Acquired on the Phoenix ICON · pediatric retinal photograph (wide-field)
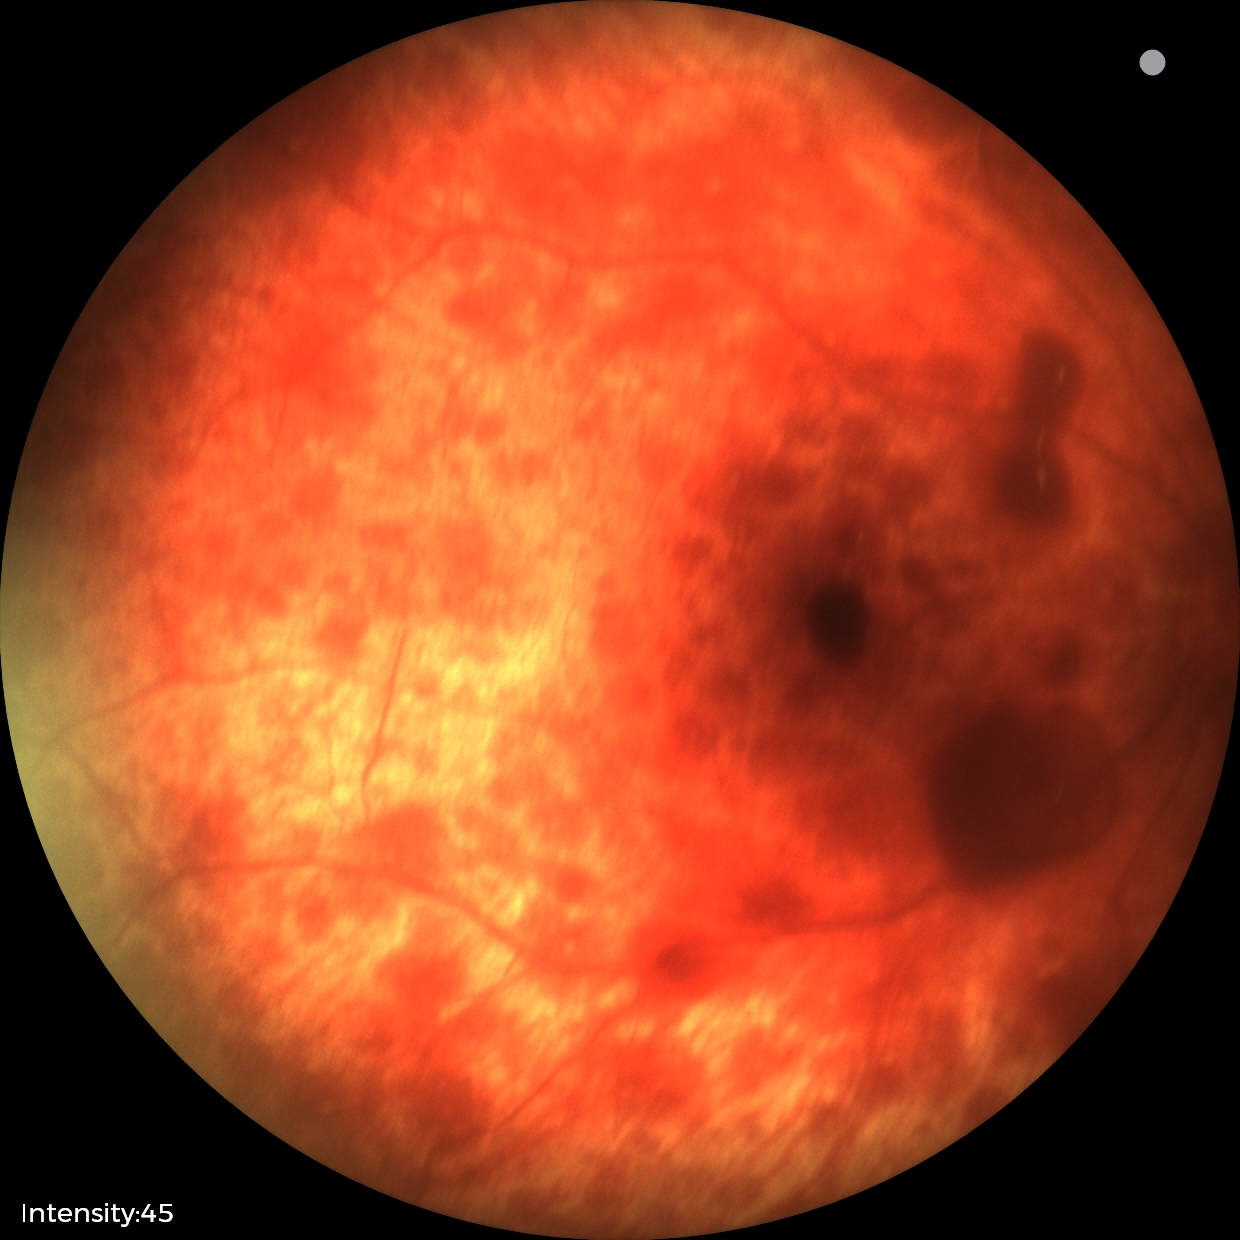
Diagnosis from this screening exam: retinal hemorrhages.